Fundus photo, FOV: 45 degrees:
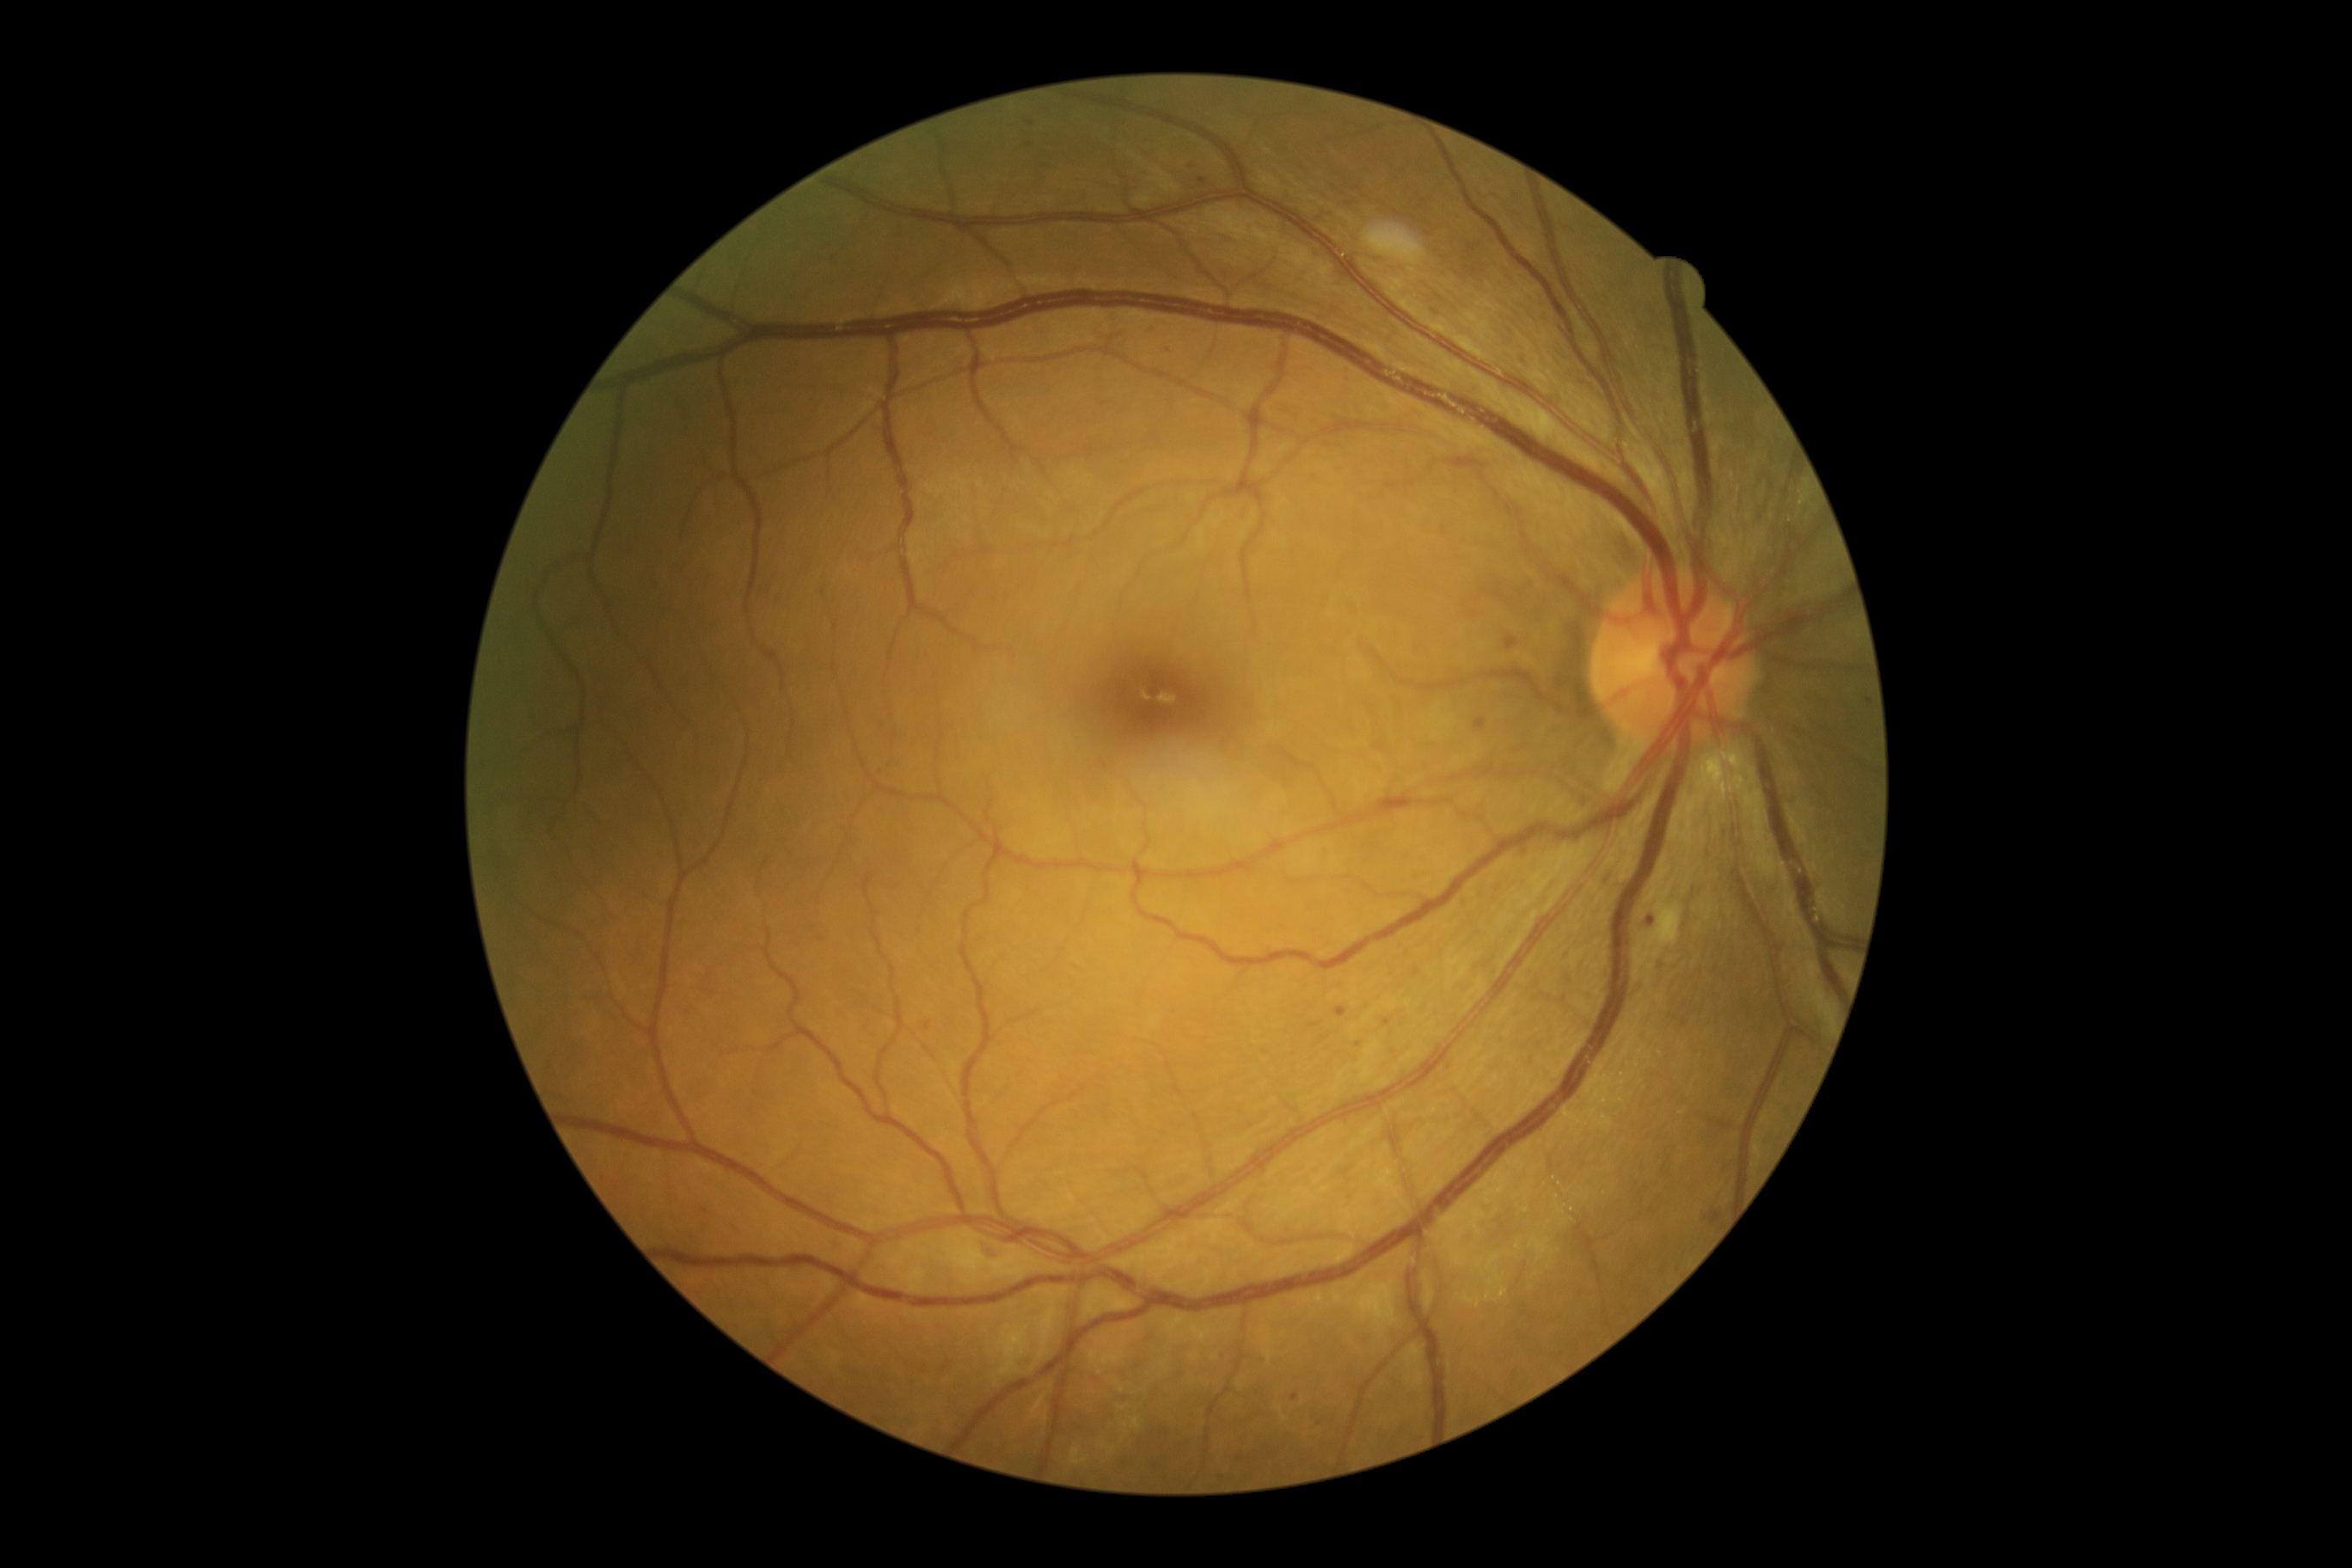

Diabetic retinopathy (DR): moderate non-proliferative diabetic retinopathy (grade 2)
Lesions identified (partial list):
microaneurysms (MAs) (continued): x1=1292 y1=1393 x2=1301 y2=1402; x1=1712 y1=1211 x2=1722 y2=1225; x1=1519 y1=357 x2=1528 y2=367; x1=1335 y1=1007 x2=1347 y2=1019; x1=1412 y1=969 x2=1419 y2=979; x1=1865 y1=694 x2=1870 y2=704; x1=1474 y1=718 x2=1486 y2=732; x1=1505 y1=637 x2=1514 y2=651; x1=926 y1=1022 x2=931 y2=1032
Small MAs approximately at point(1030, 123); point(1358, 1044); point(706, 1212); point(1319, 1424)